Graded on the modified Davis scale; 848 by 848 pixels; fundus photo; acquired with a NIDEK AFC-230:
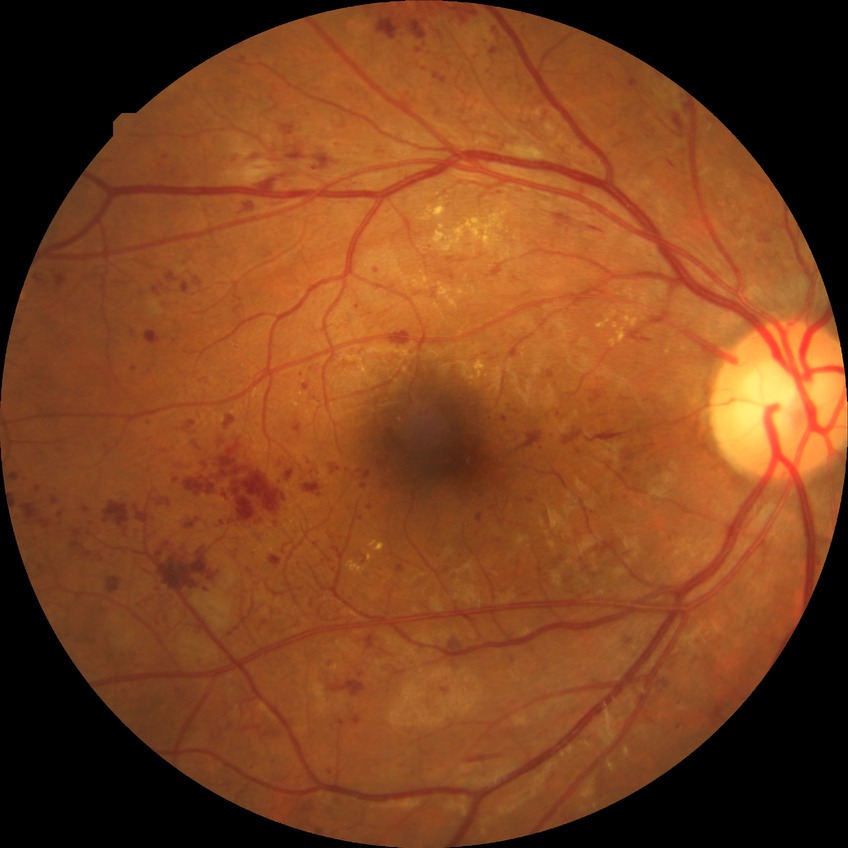 Retinopathy stage is proliferative diabetic retinopathy.